2212x1659px: 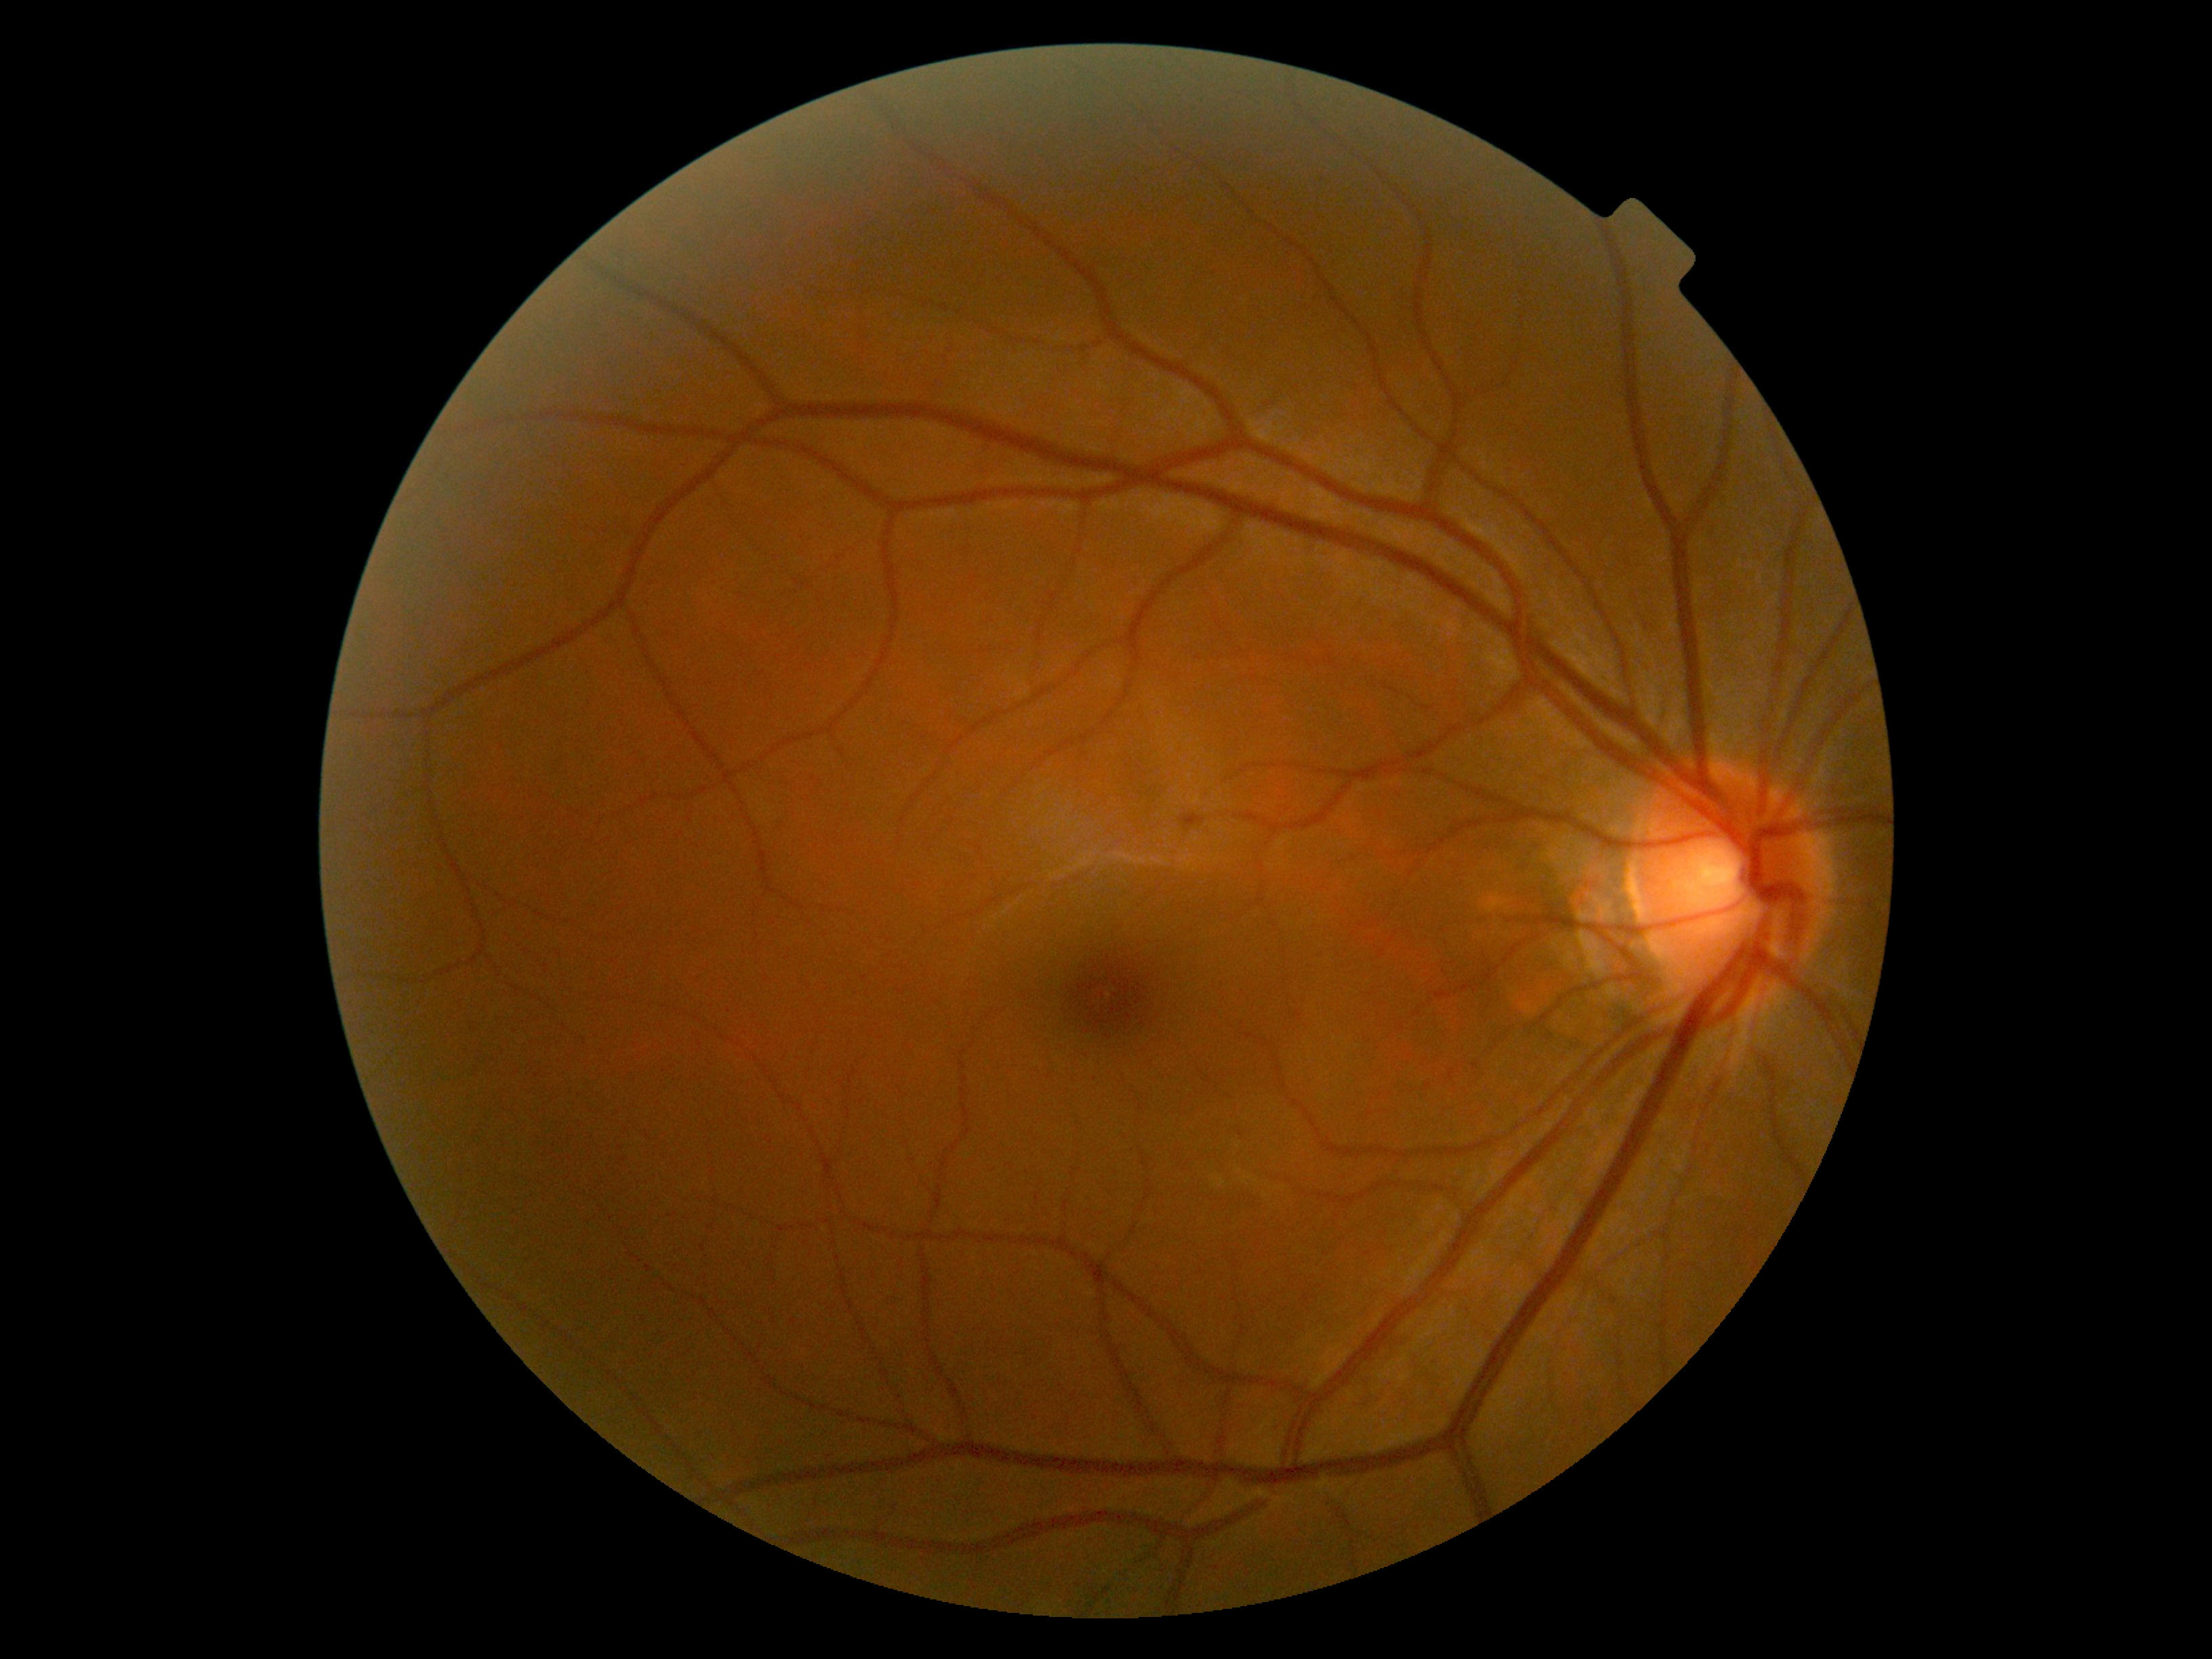

retinopathy grade: 0 (no apparent retinopathy) — no visible signs of diabetic retinopathy.